Color fundus image · 45-degree field of view · 2346 by 1568 pixels — 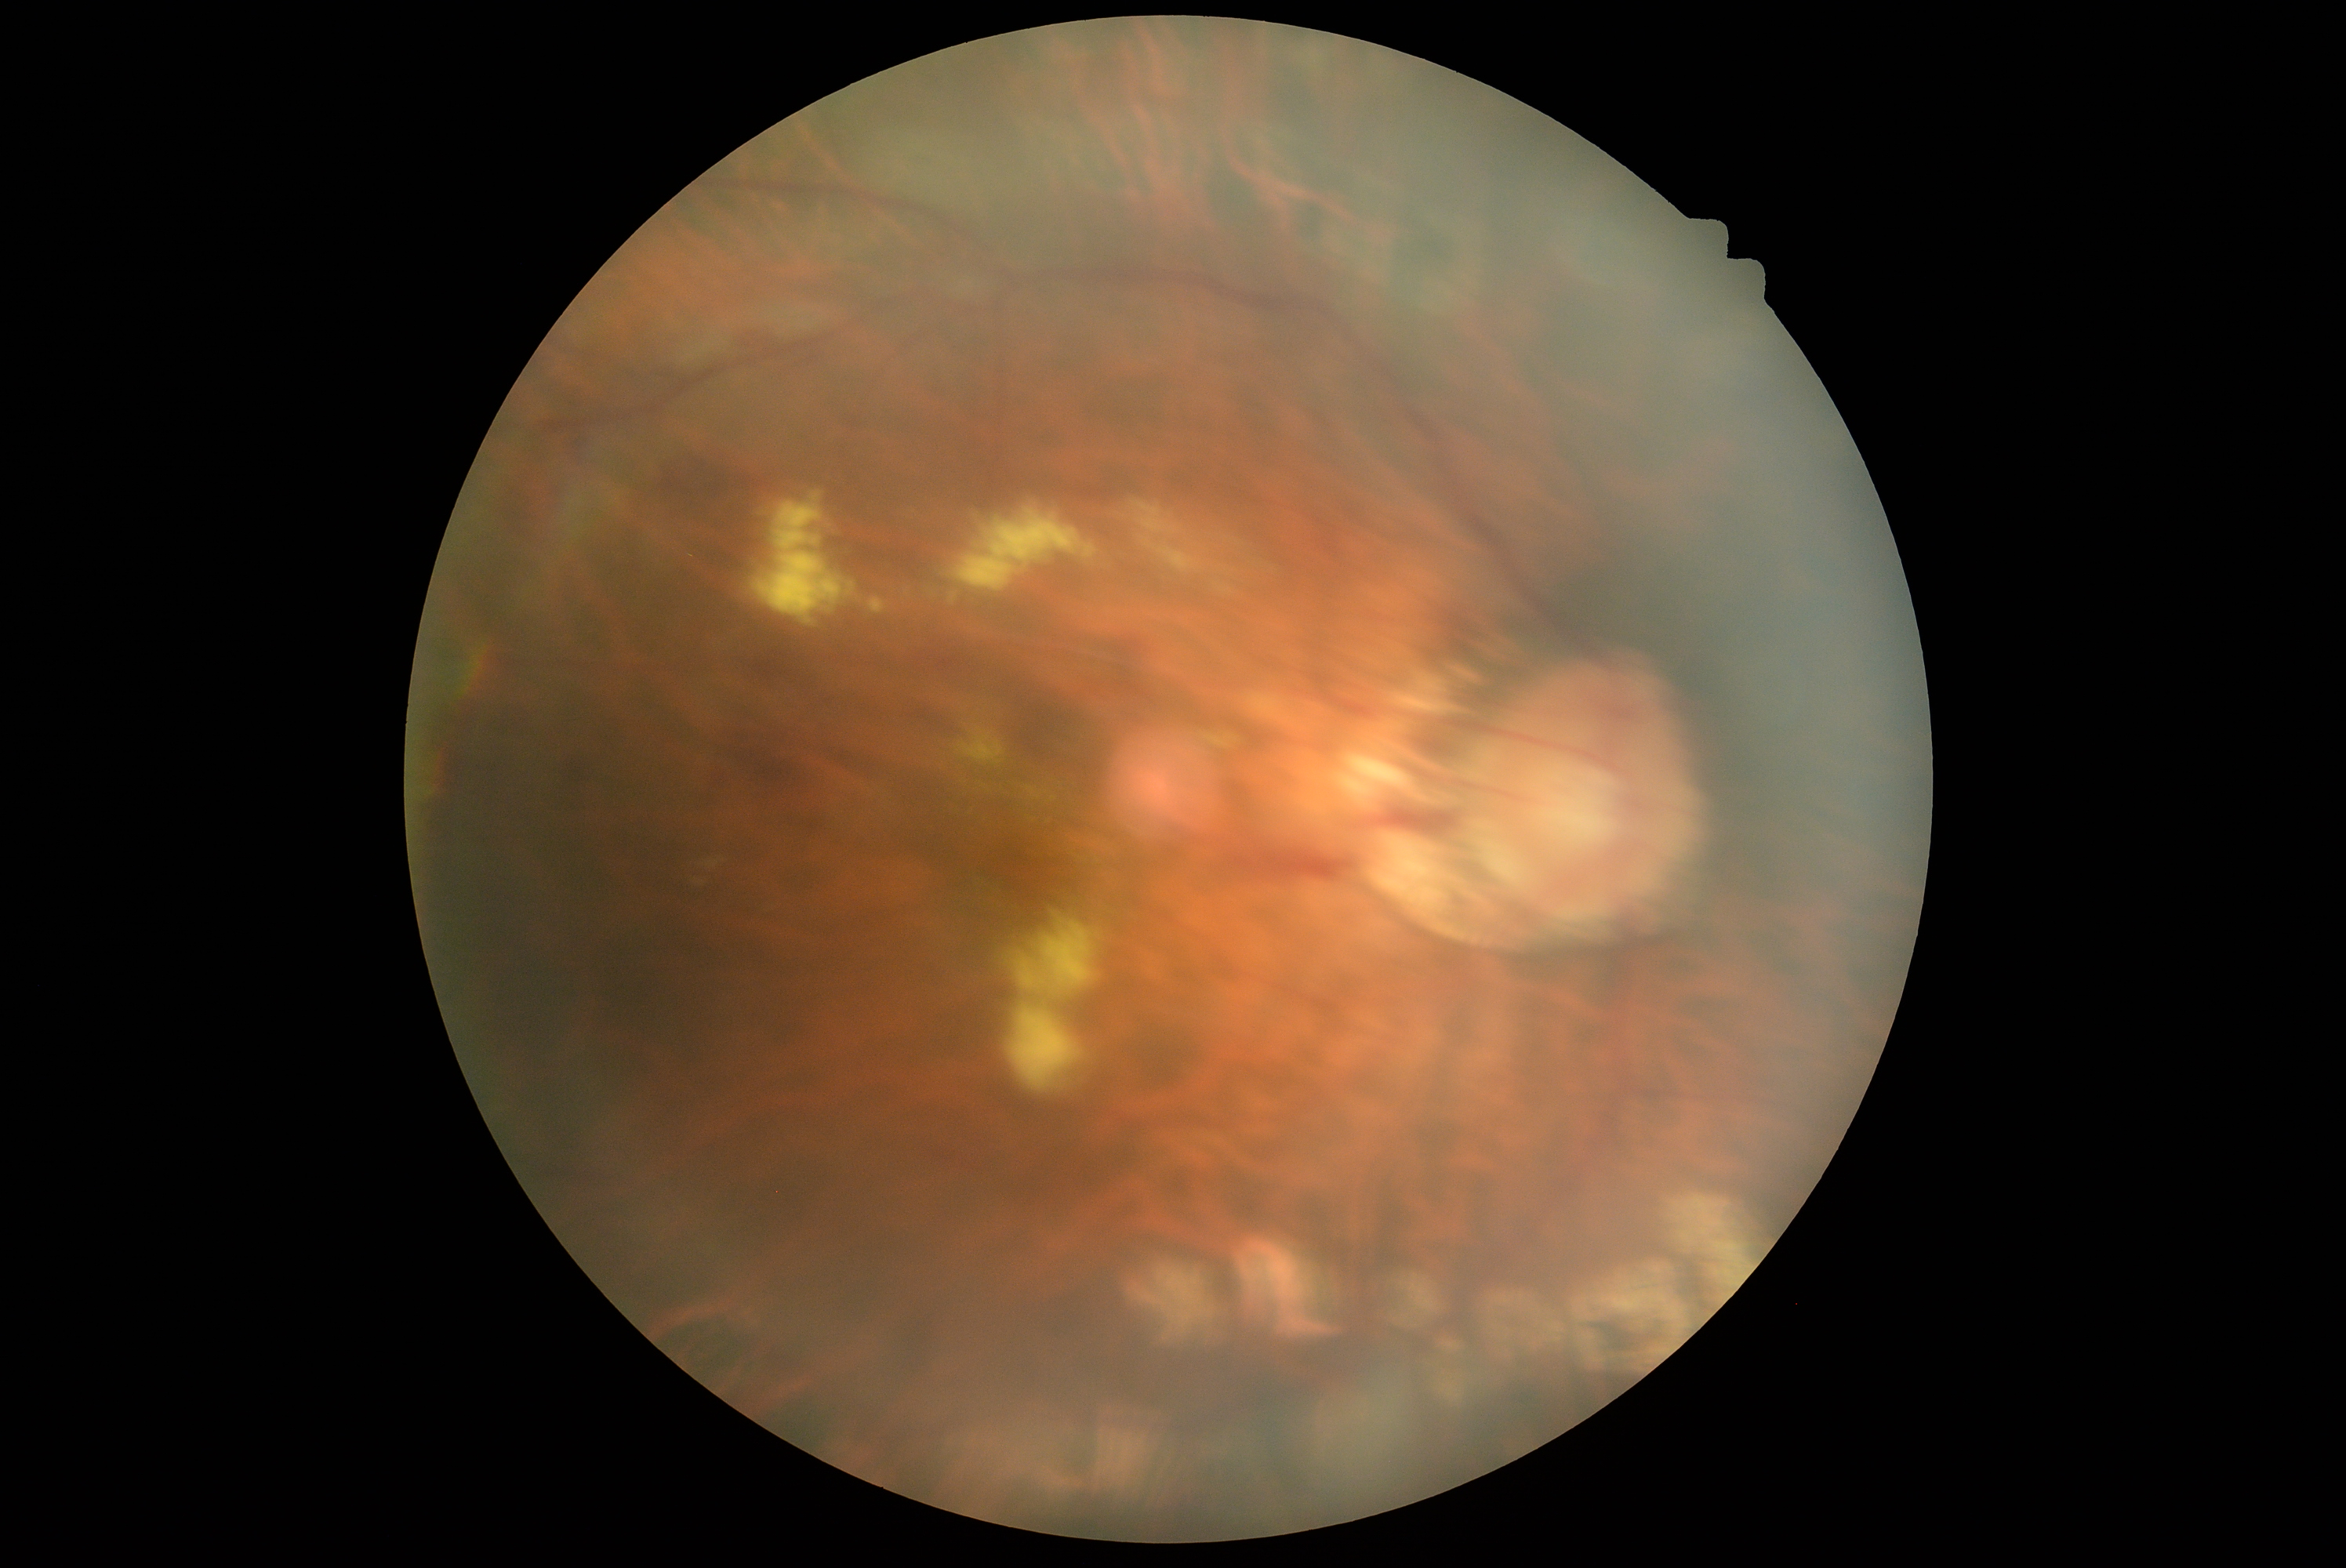 Retinopathy grade is 2.